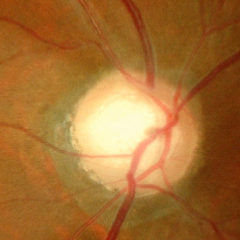 Glaucoma diagnosis: advanced glaucomatous optic neuropathy. (Criteria: near-total cupping of the optic nerve head, with or without severe visual field loss within the central 10 degrees of fixation.)